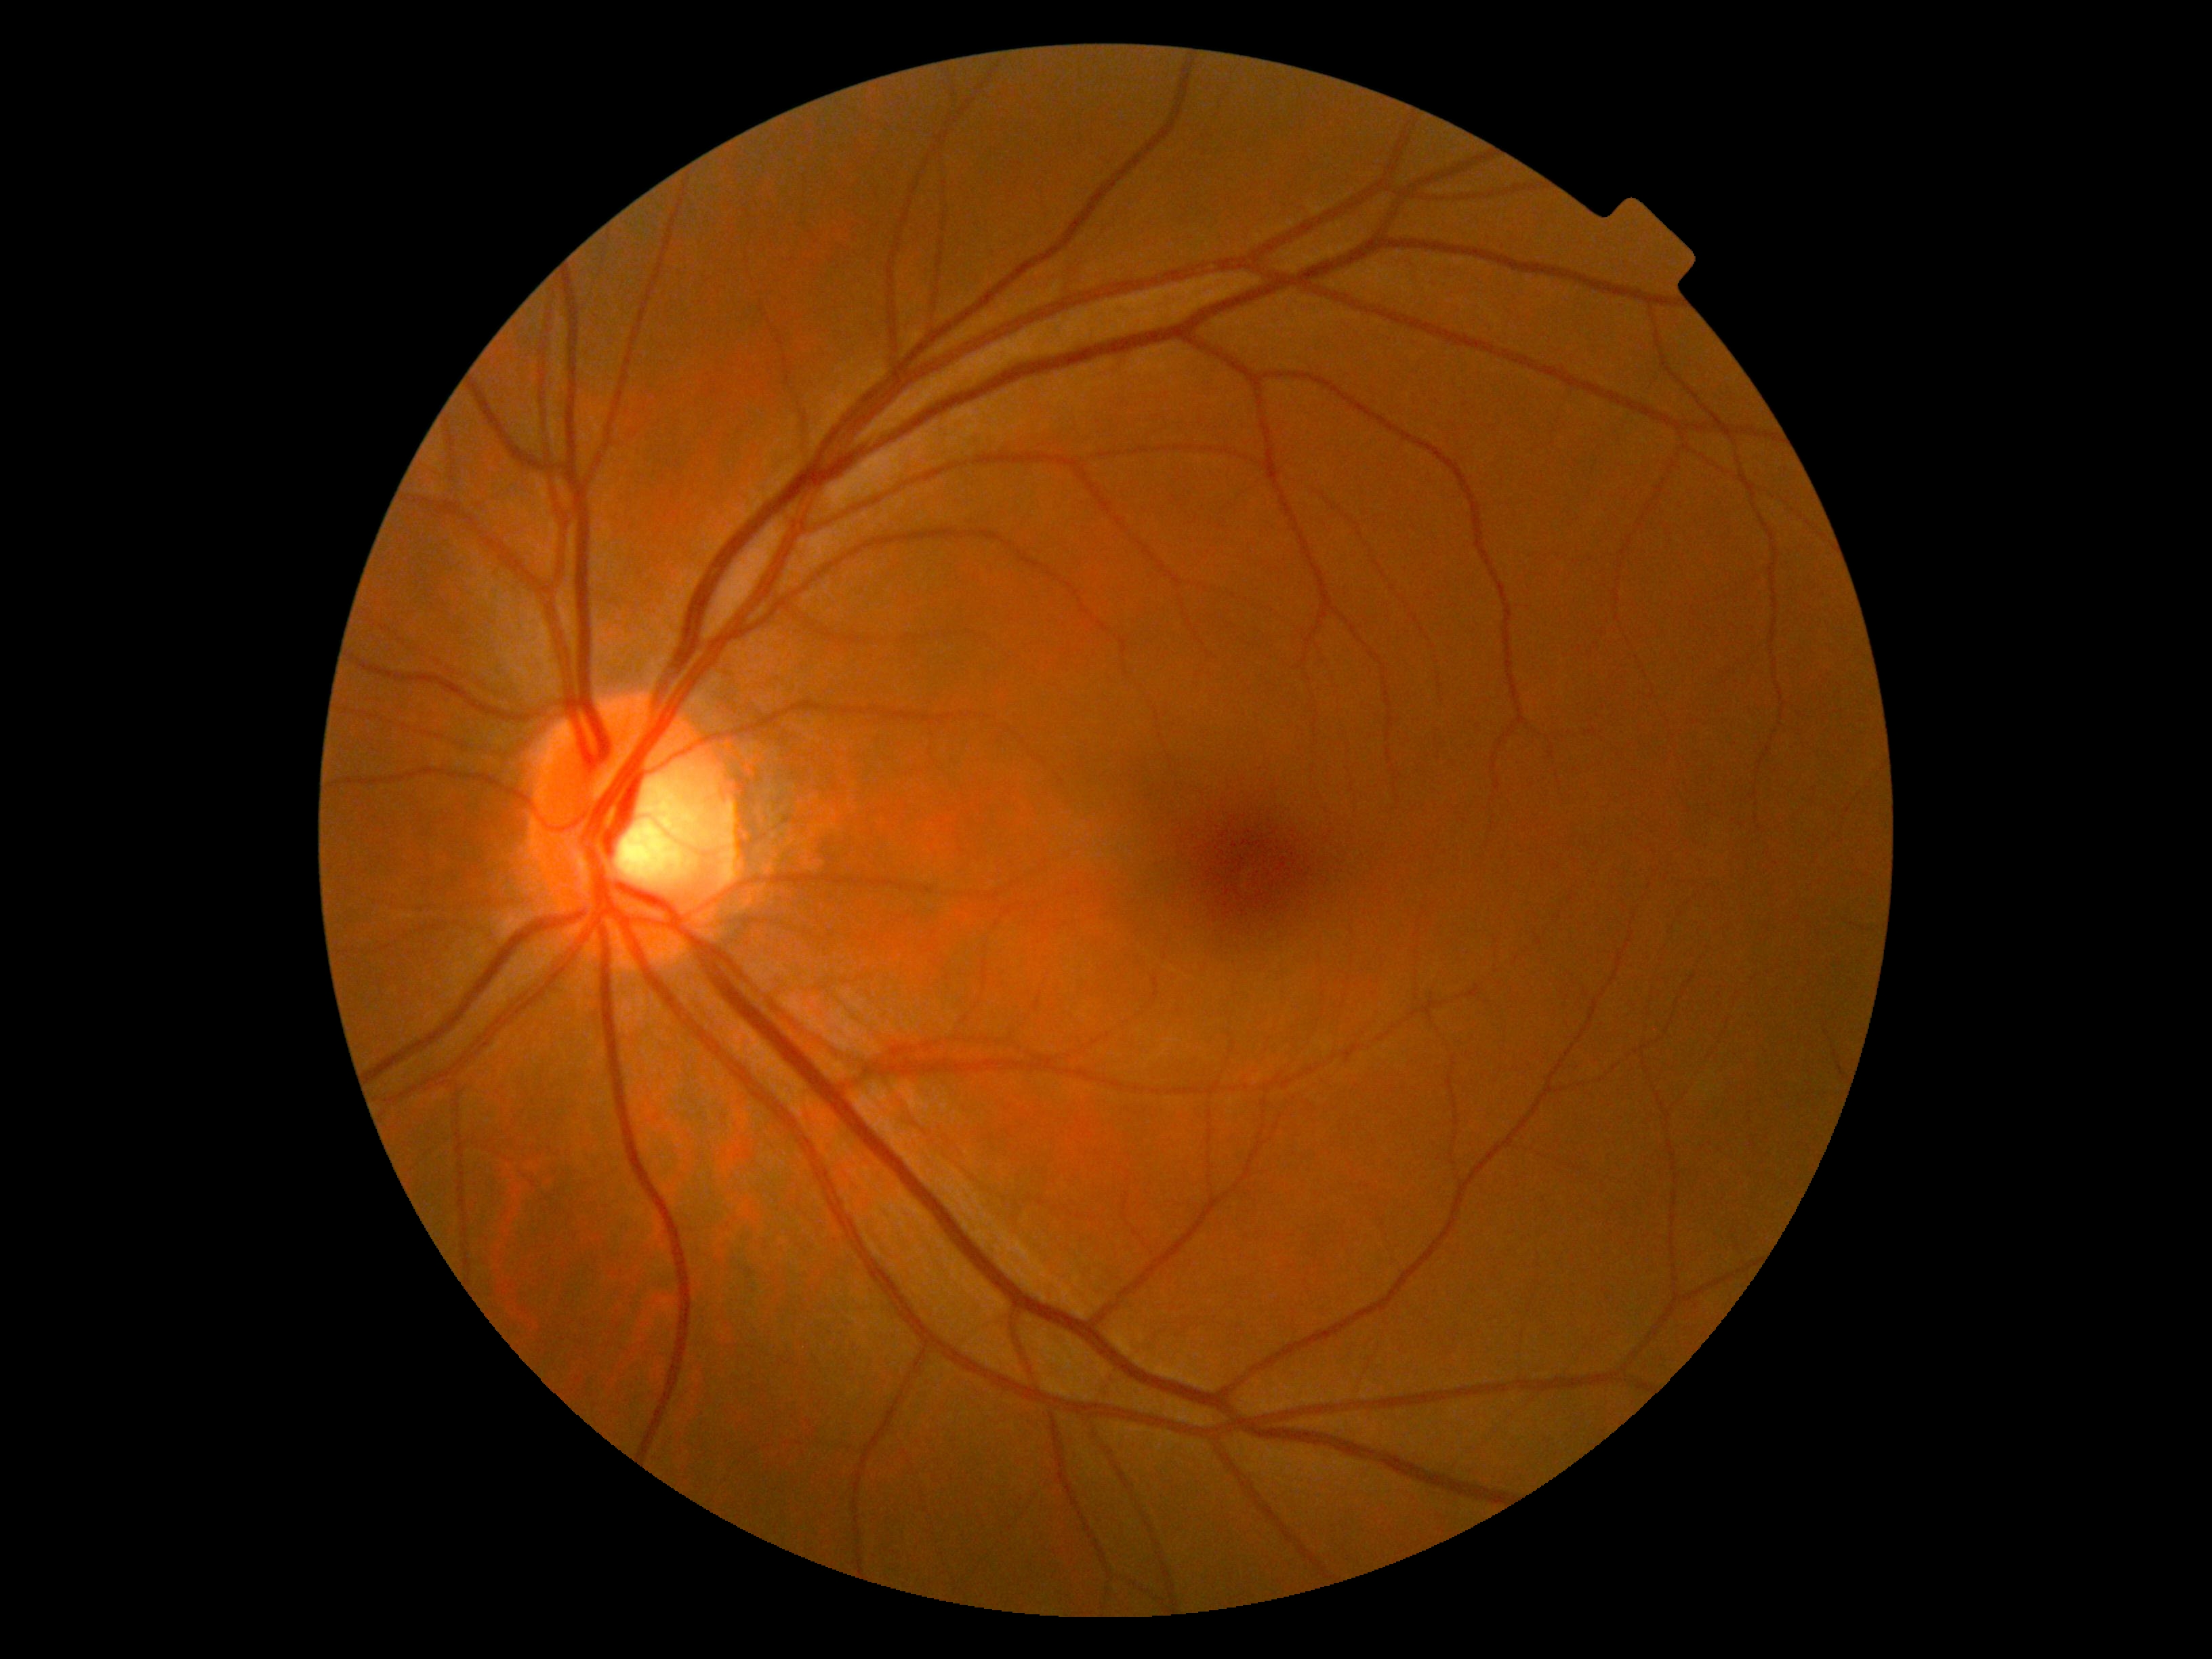 DR stage: grade 0 (no apparent retinopathy).